Pediatric wide-field fundus photograph: 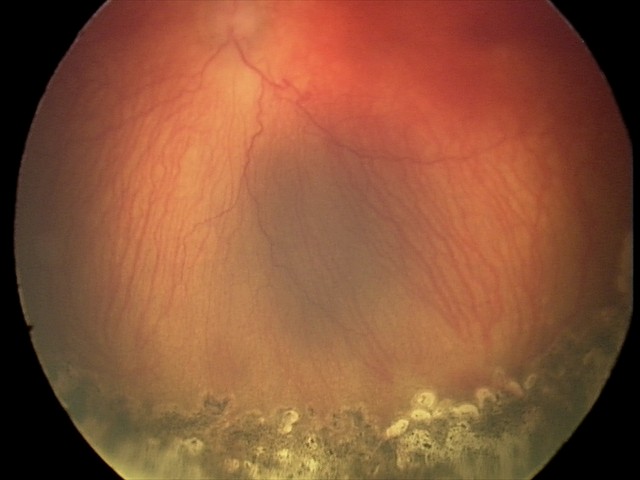
Screening series with aggressive retinopathy of prematurity.